2048 x 1536 pixels: 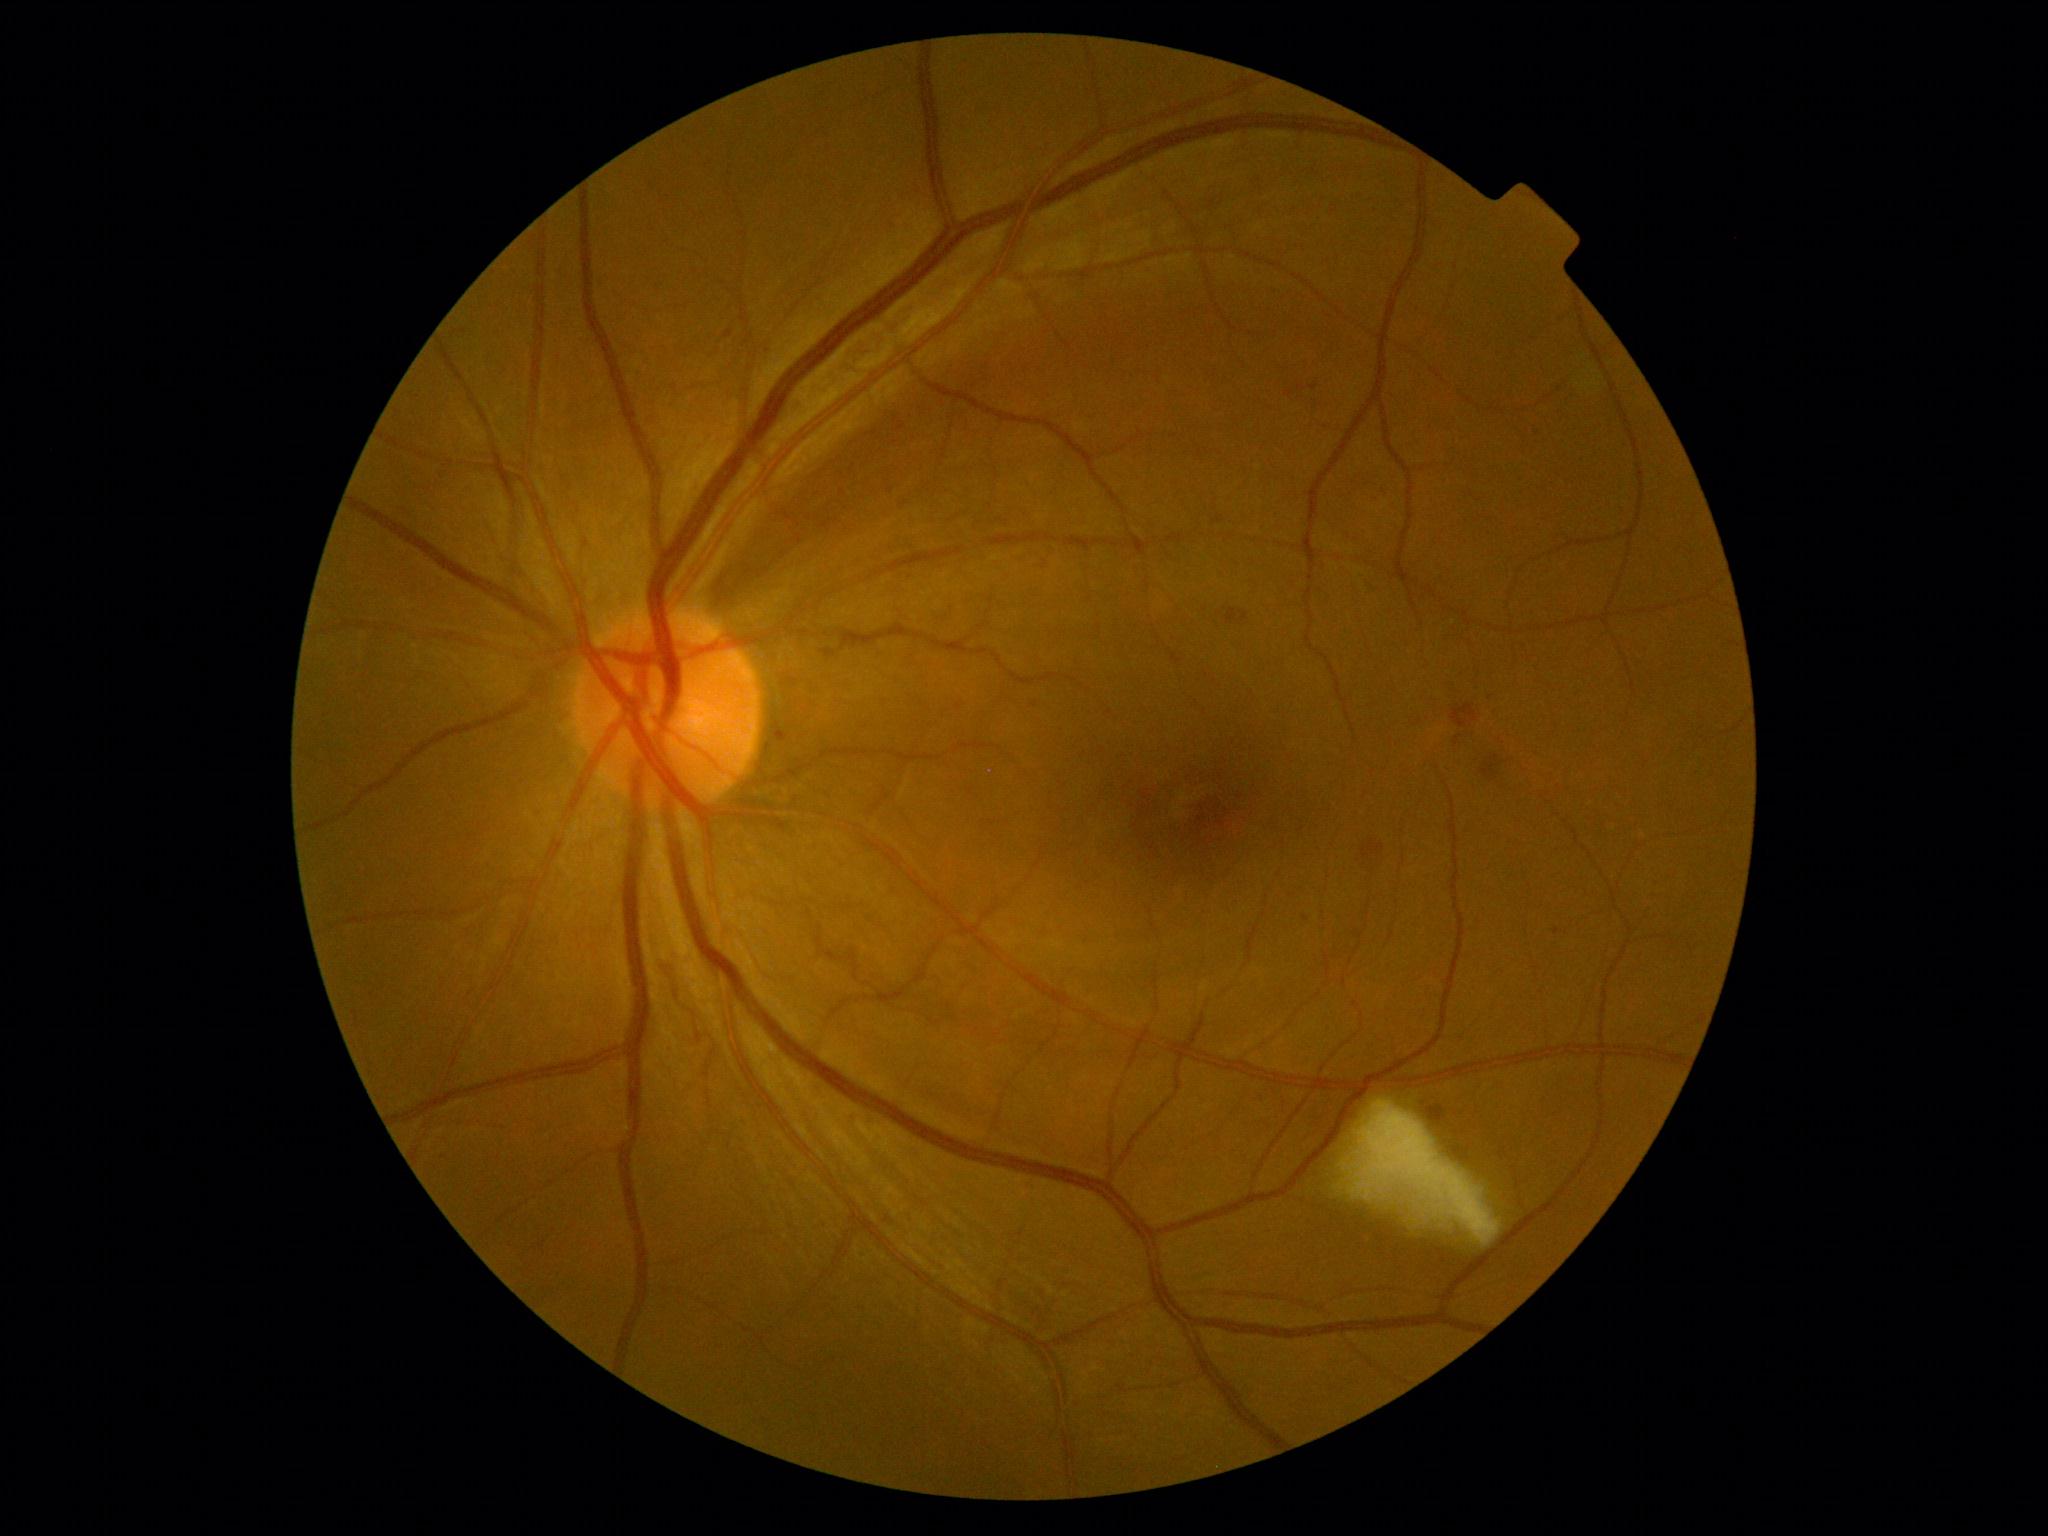 dr_grade: moderate NPDR (2) — more than just microaneurysms but less than severe NPDR